2352x1568px:
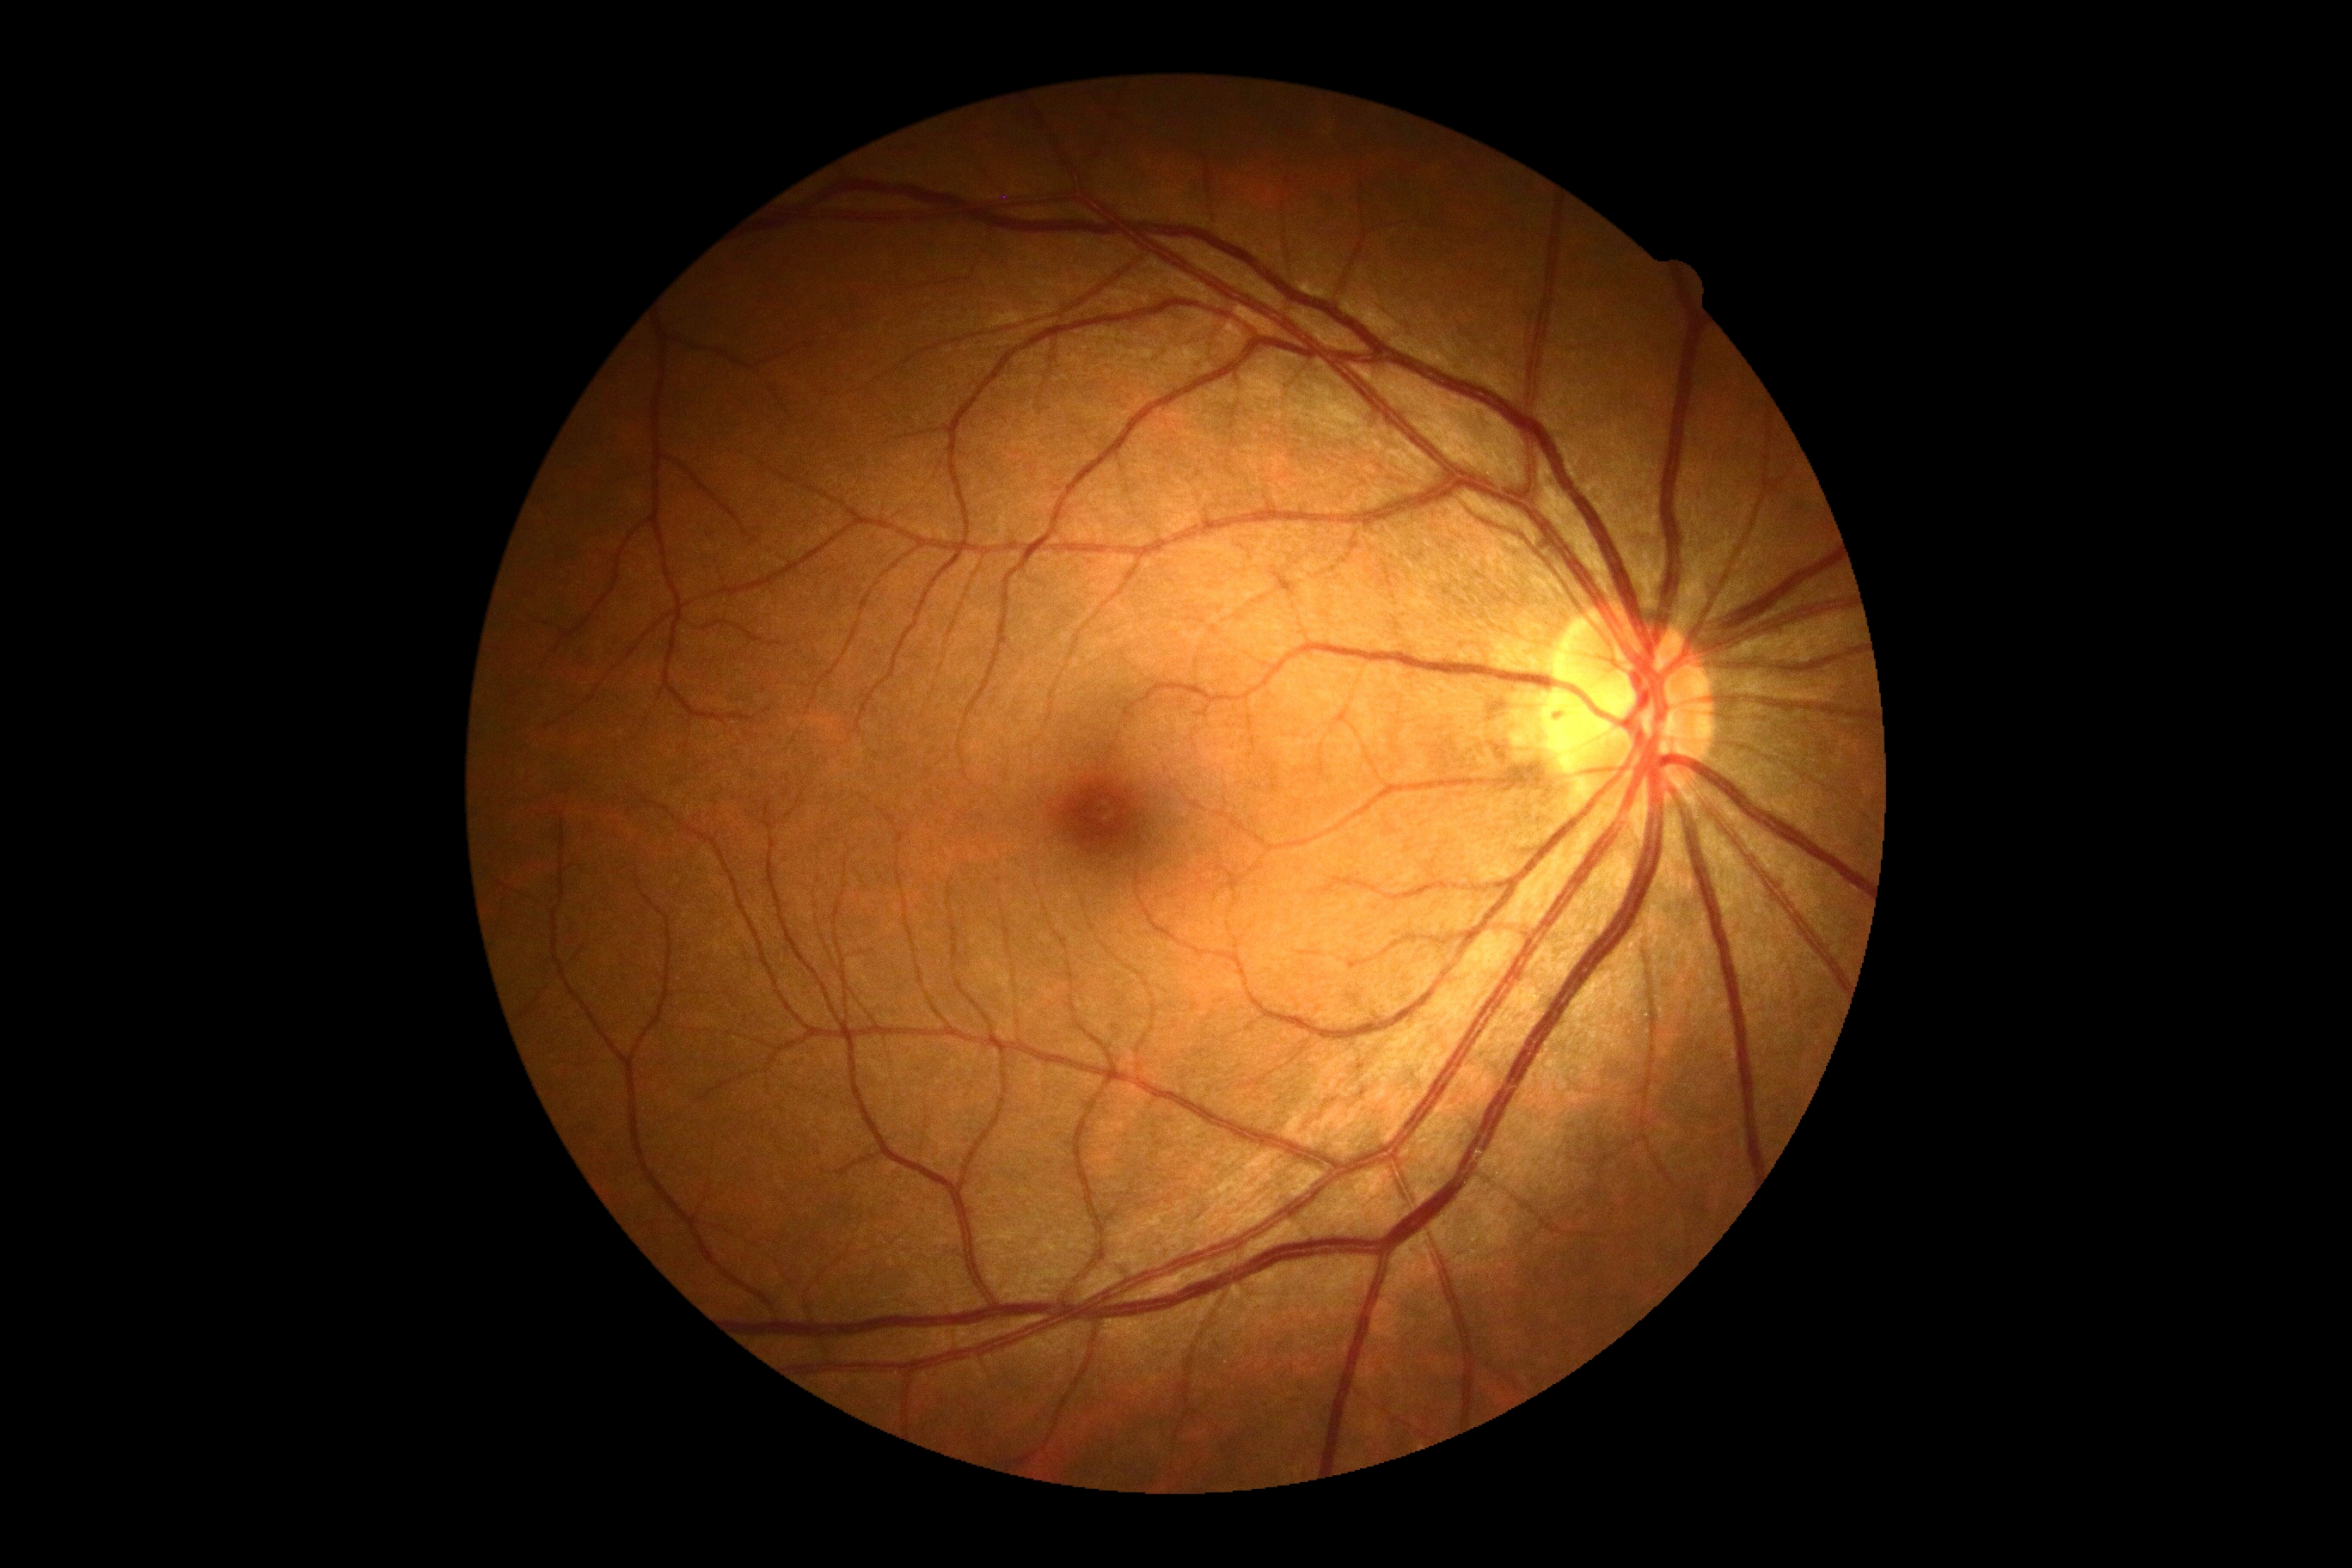
DR@0.